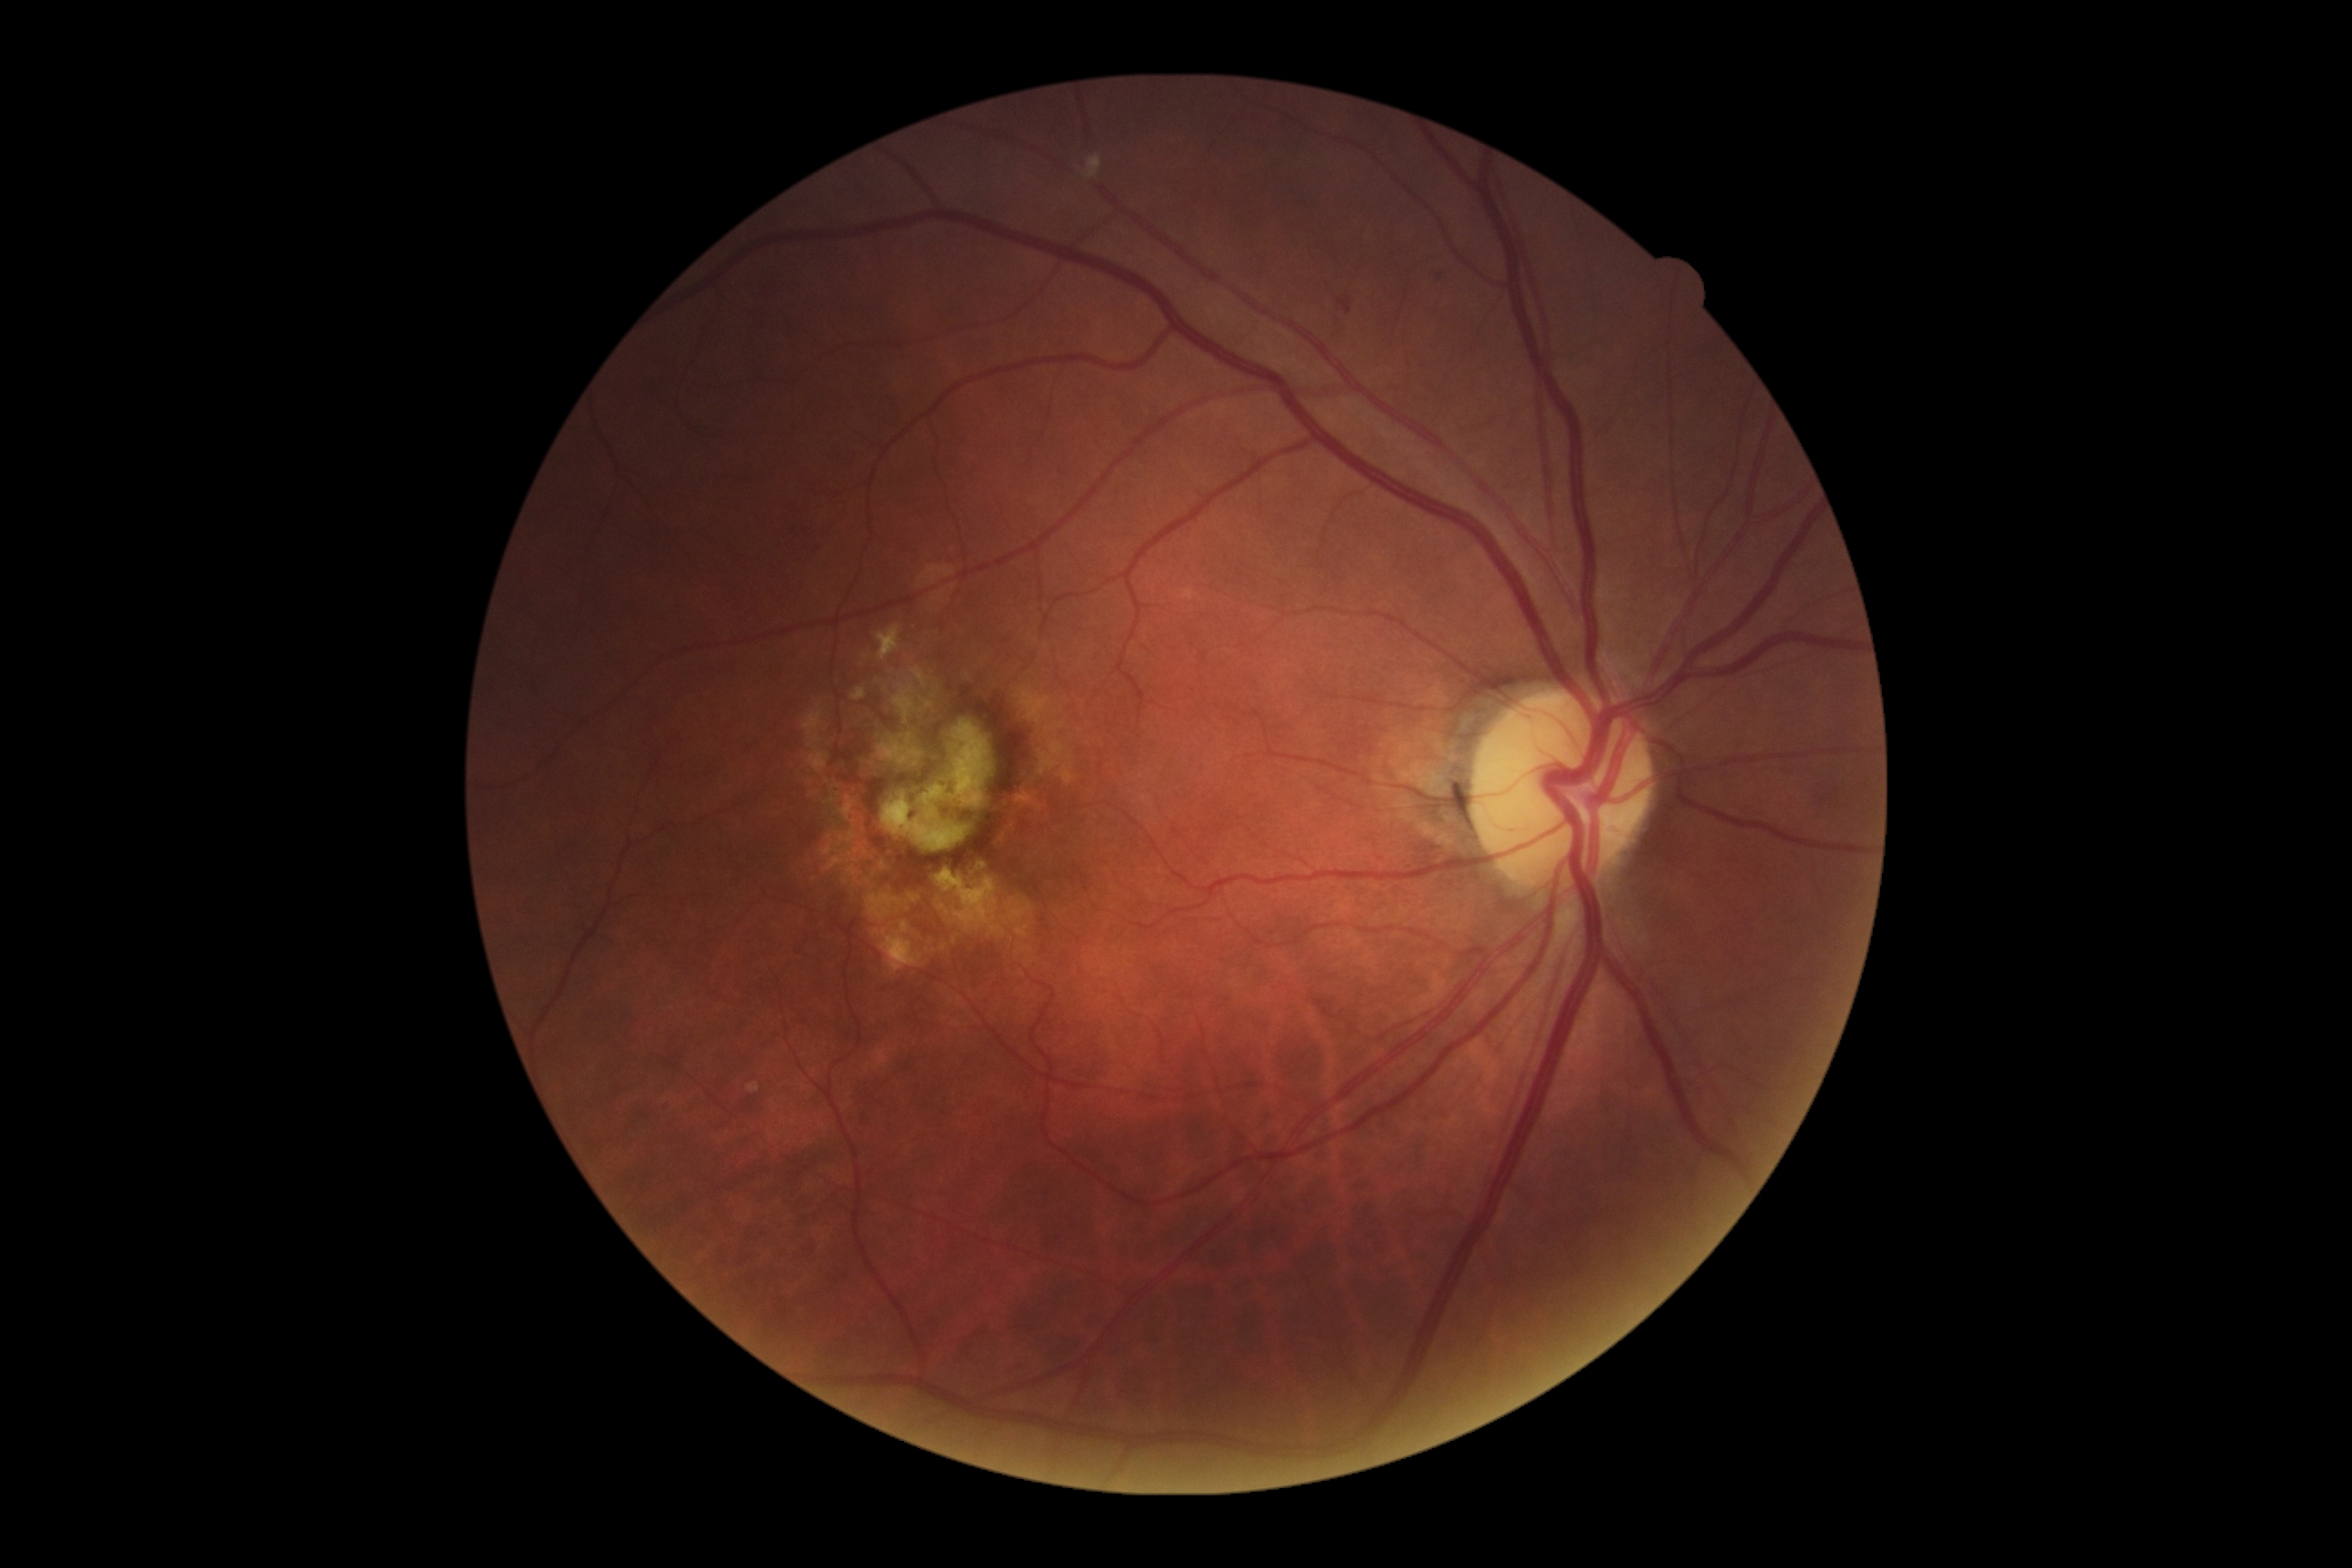 diabetic retinopathy (DR) = grade 1
DR class = non-proliferative diabetic retinopathy